45° FOV. Nonmydriatic fundus photograph. 848 x 848 pixels — 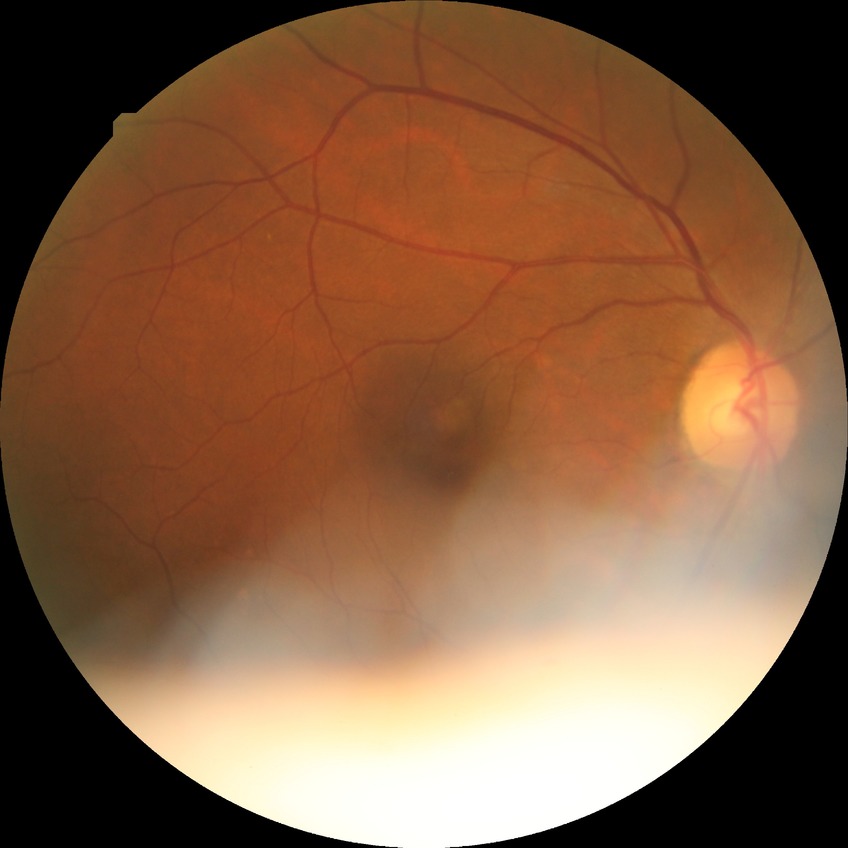

Diabetic retinopathy grade: no diabetic retinopathy.